Posterior pole photograph, 848 by 848 pixels, no pharmacologic dilation, acquired with a NIDEK AFC-230, graded on the modified Davis scale.
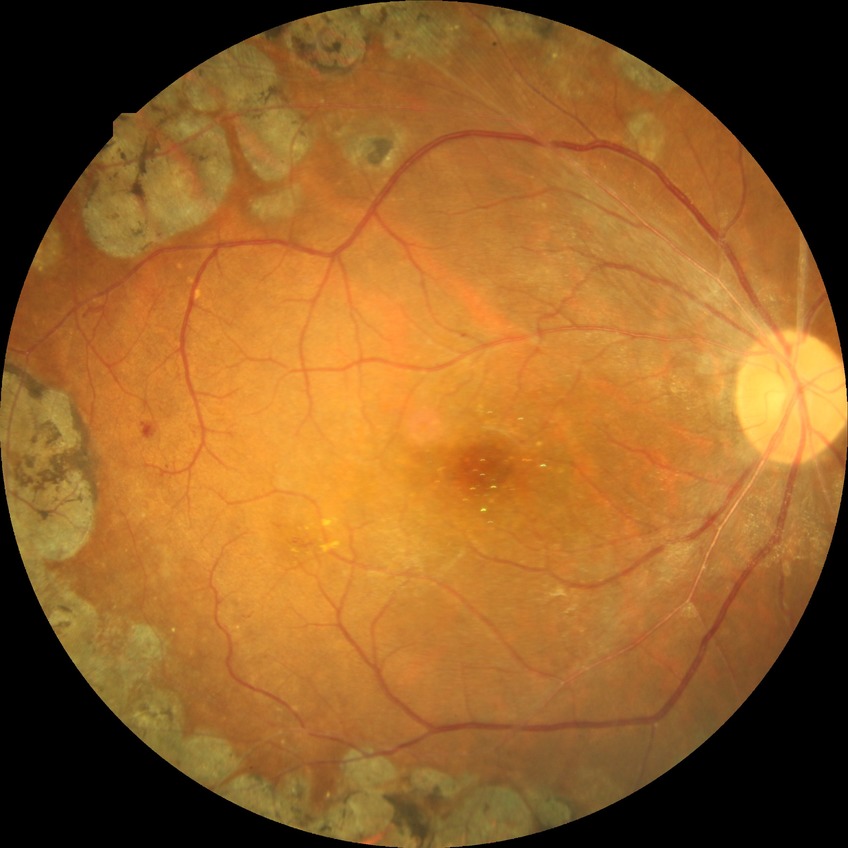 - diabetic retinopathy (DR) — PDR (proliferative diabetic retinopathy)